45° field of view; retinal fundus photograph; 2048x1536.
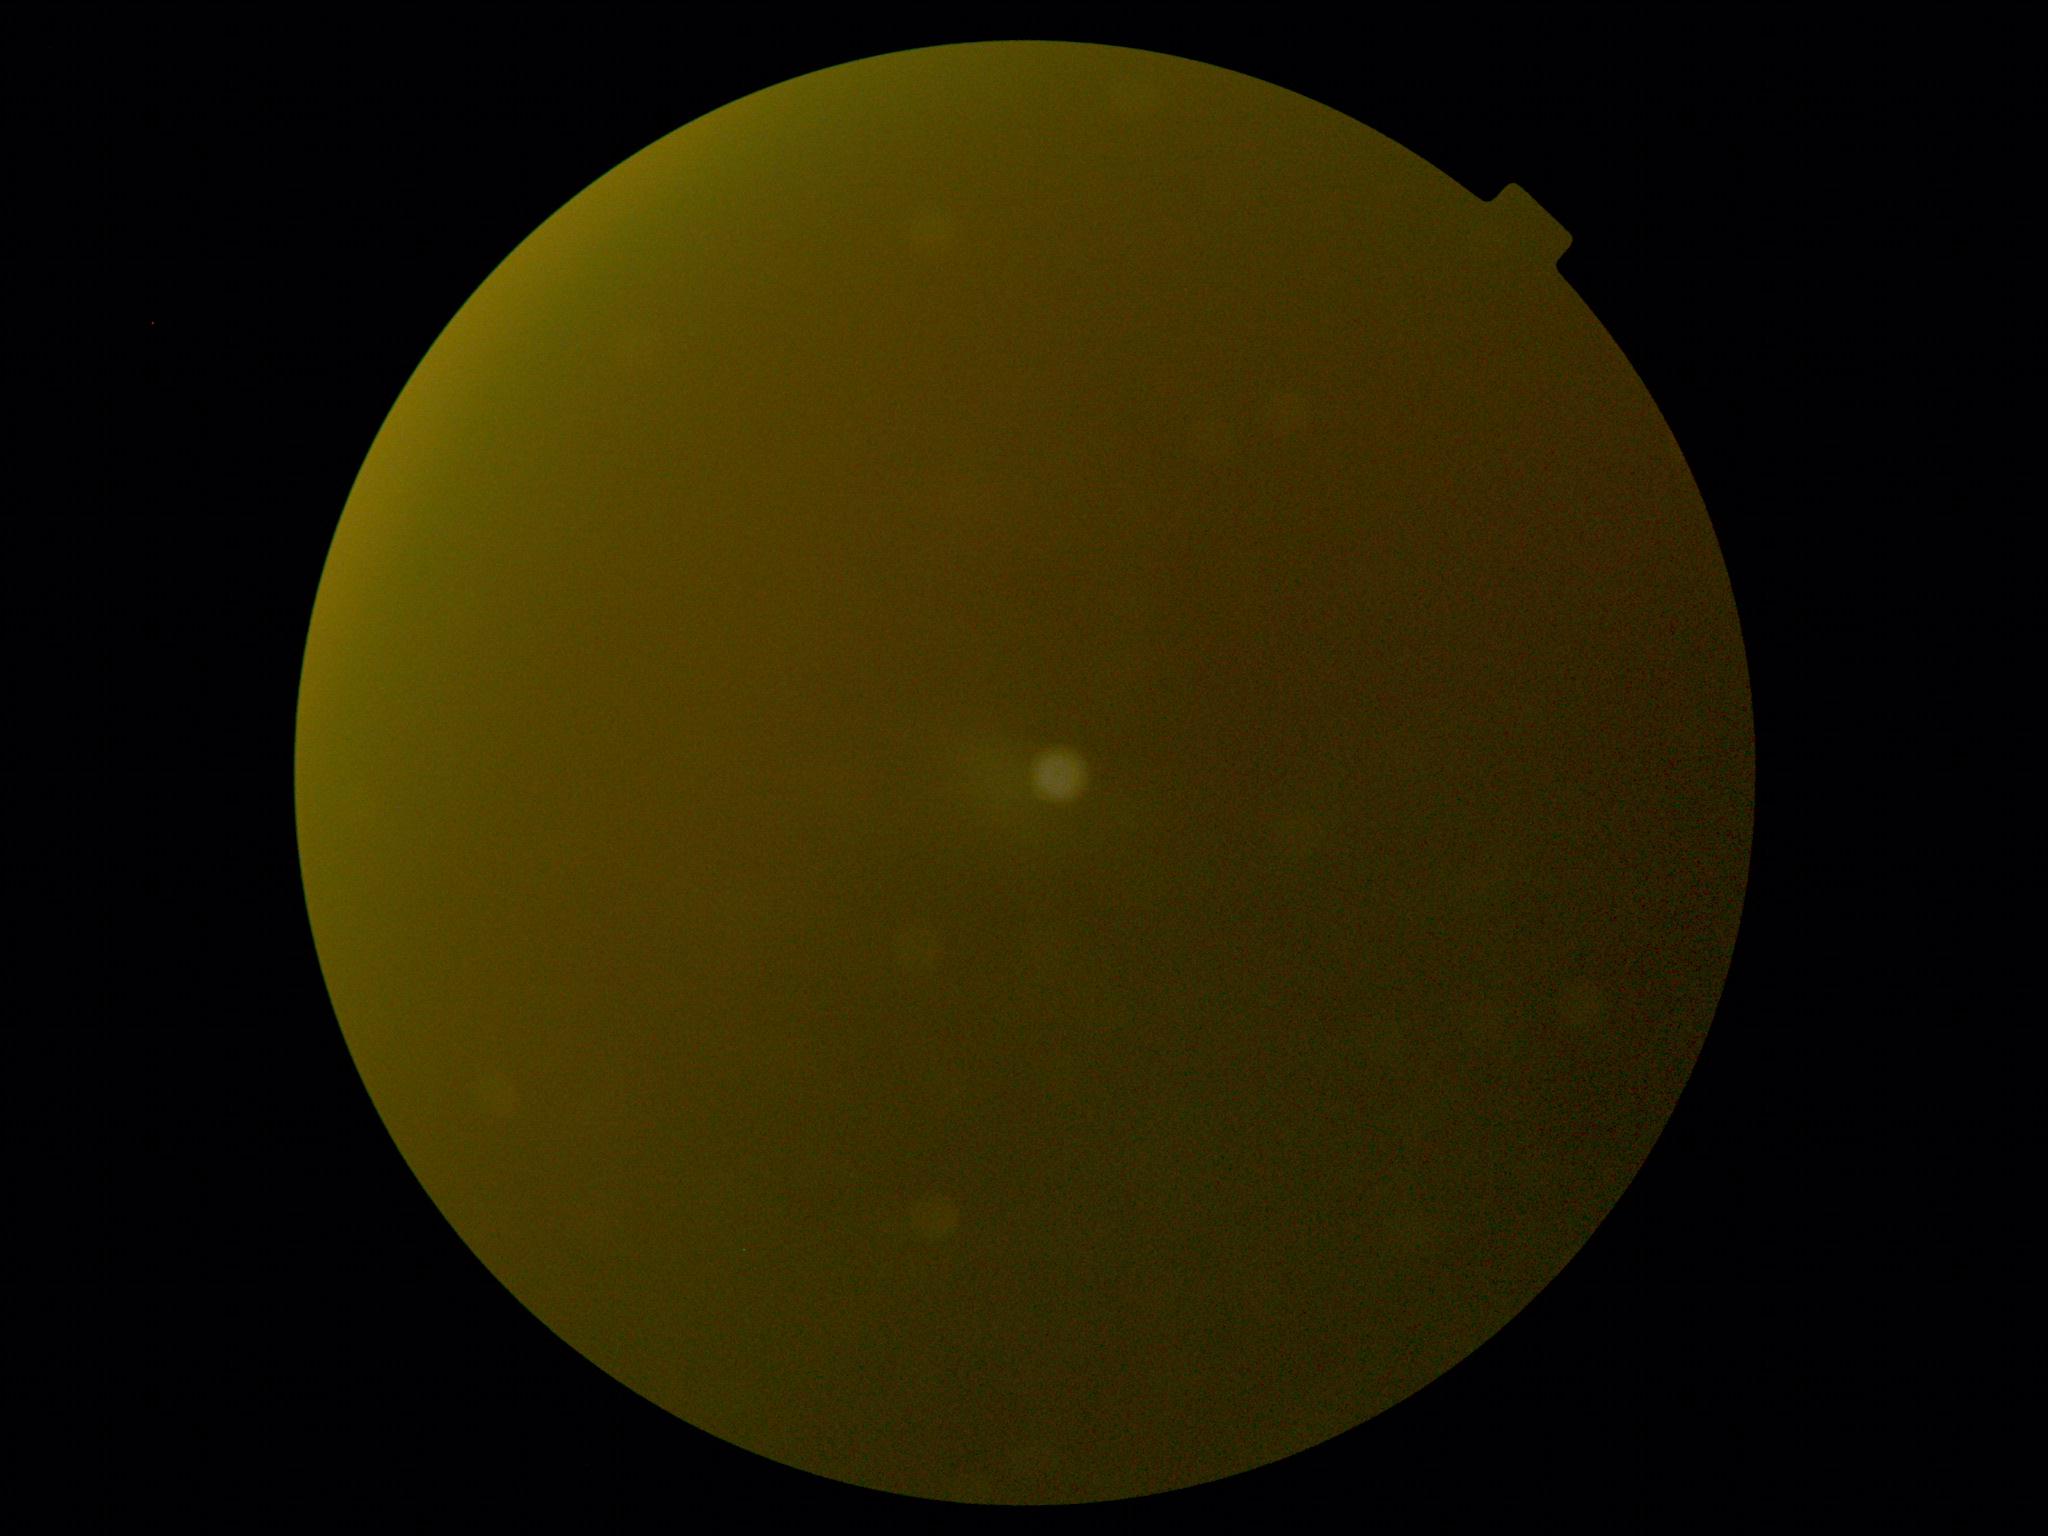

Diabetic retinopathy grade: ungradable.